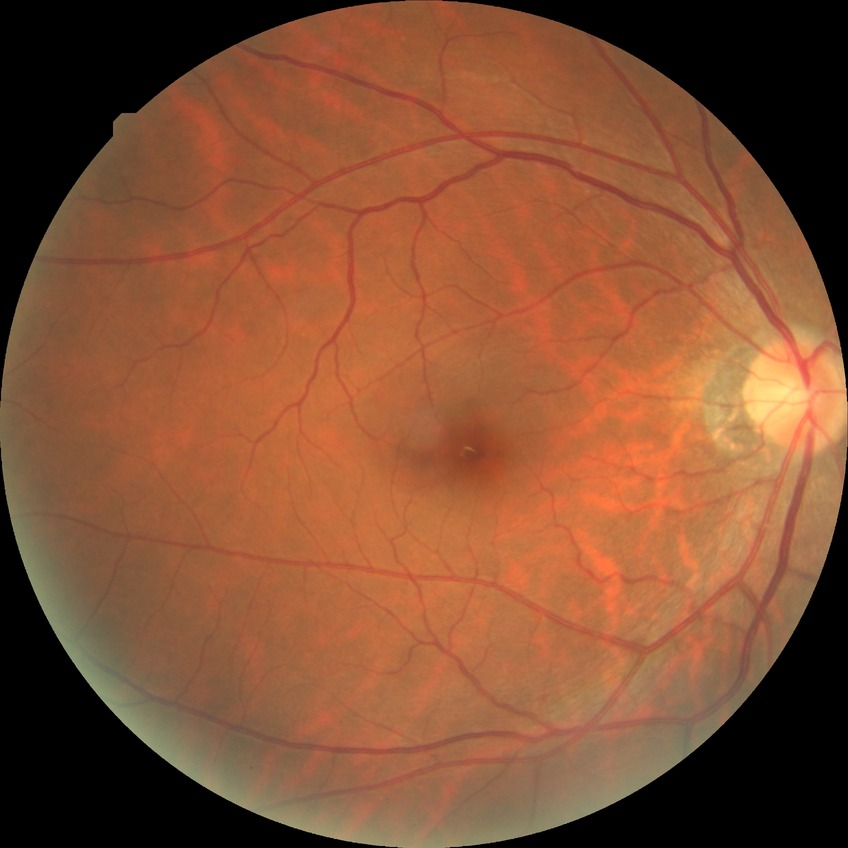
Davis grading: no diabetic retinopathy.